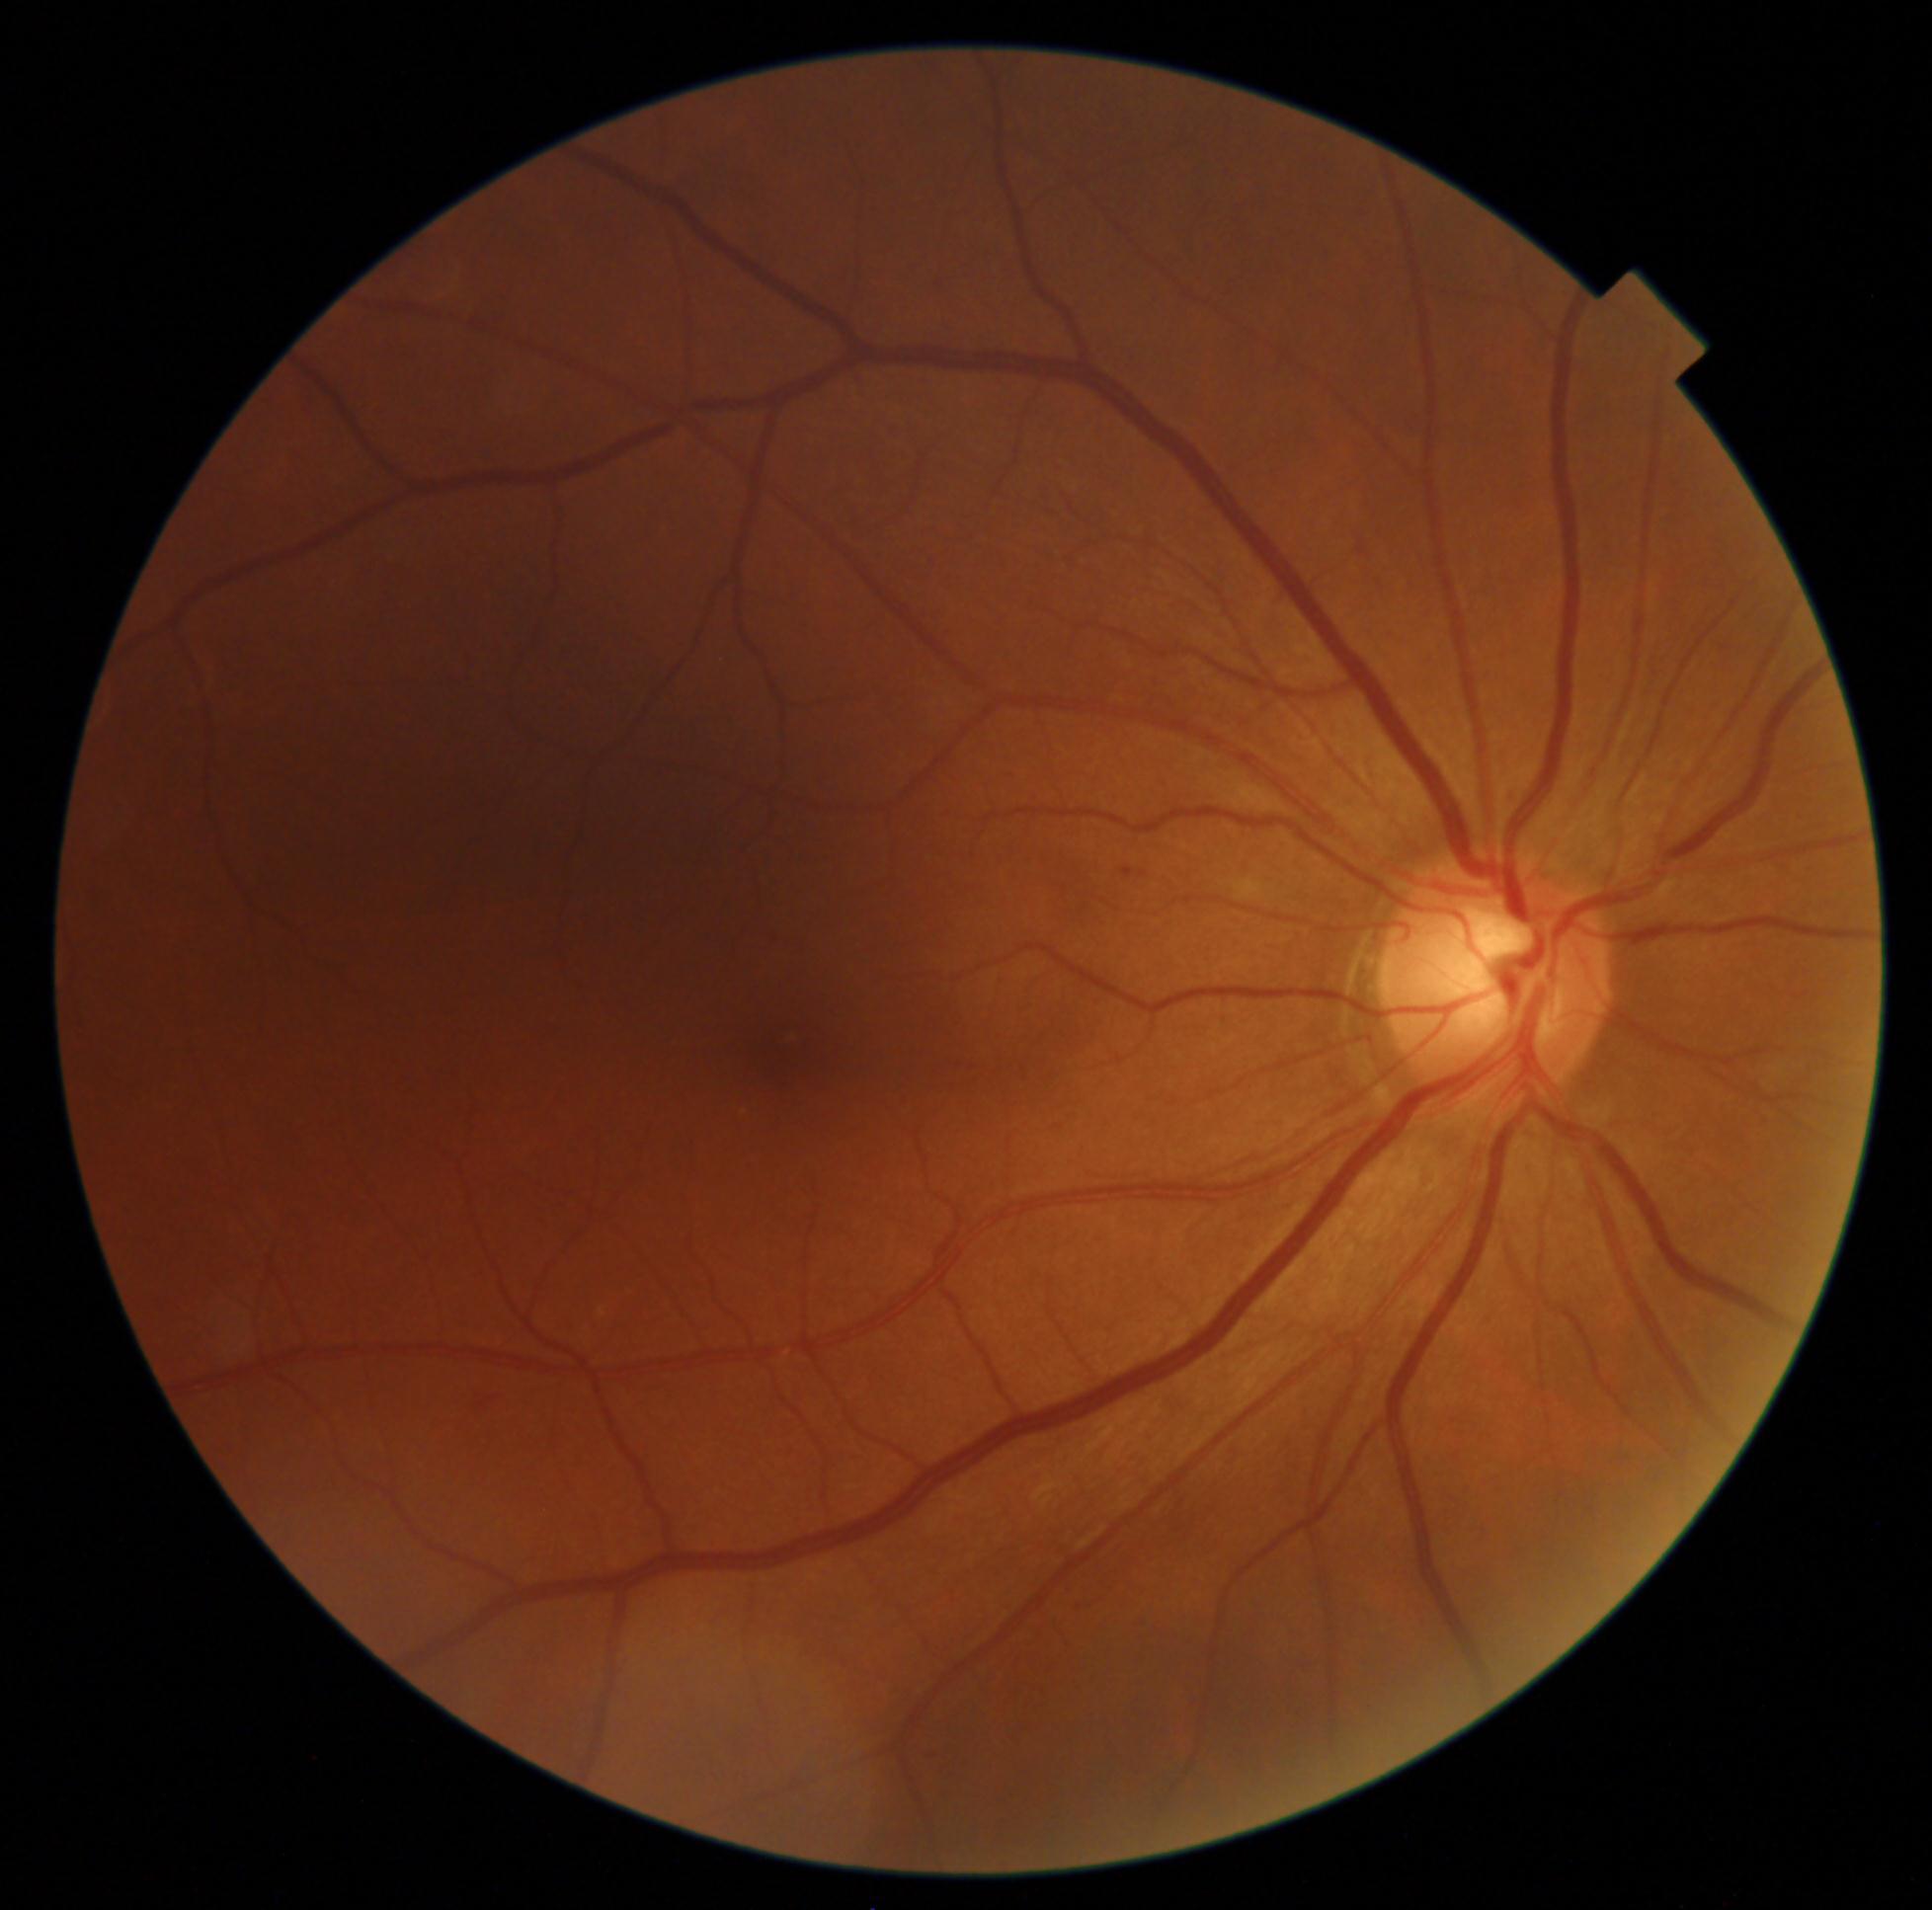 diabetic retinopathy severity: grade 1